Retinal fundus photograph.
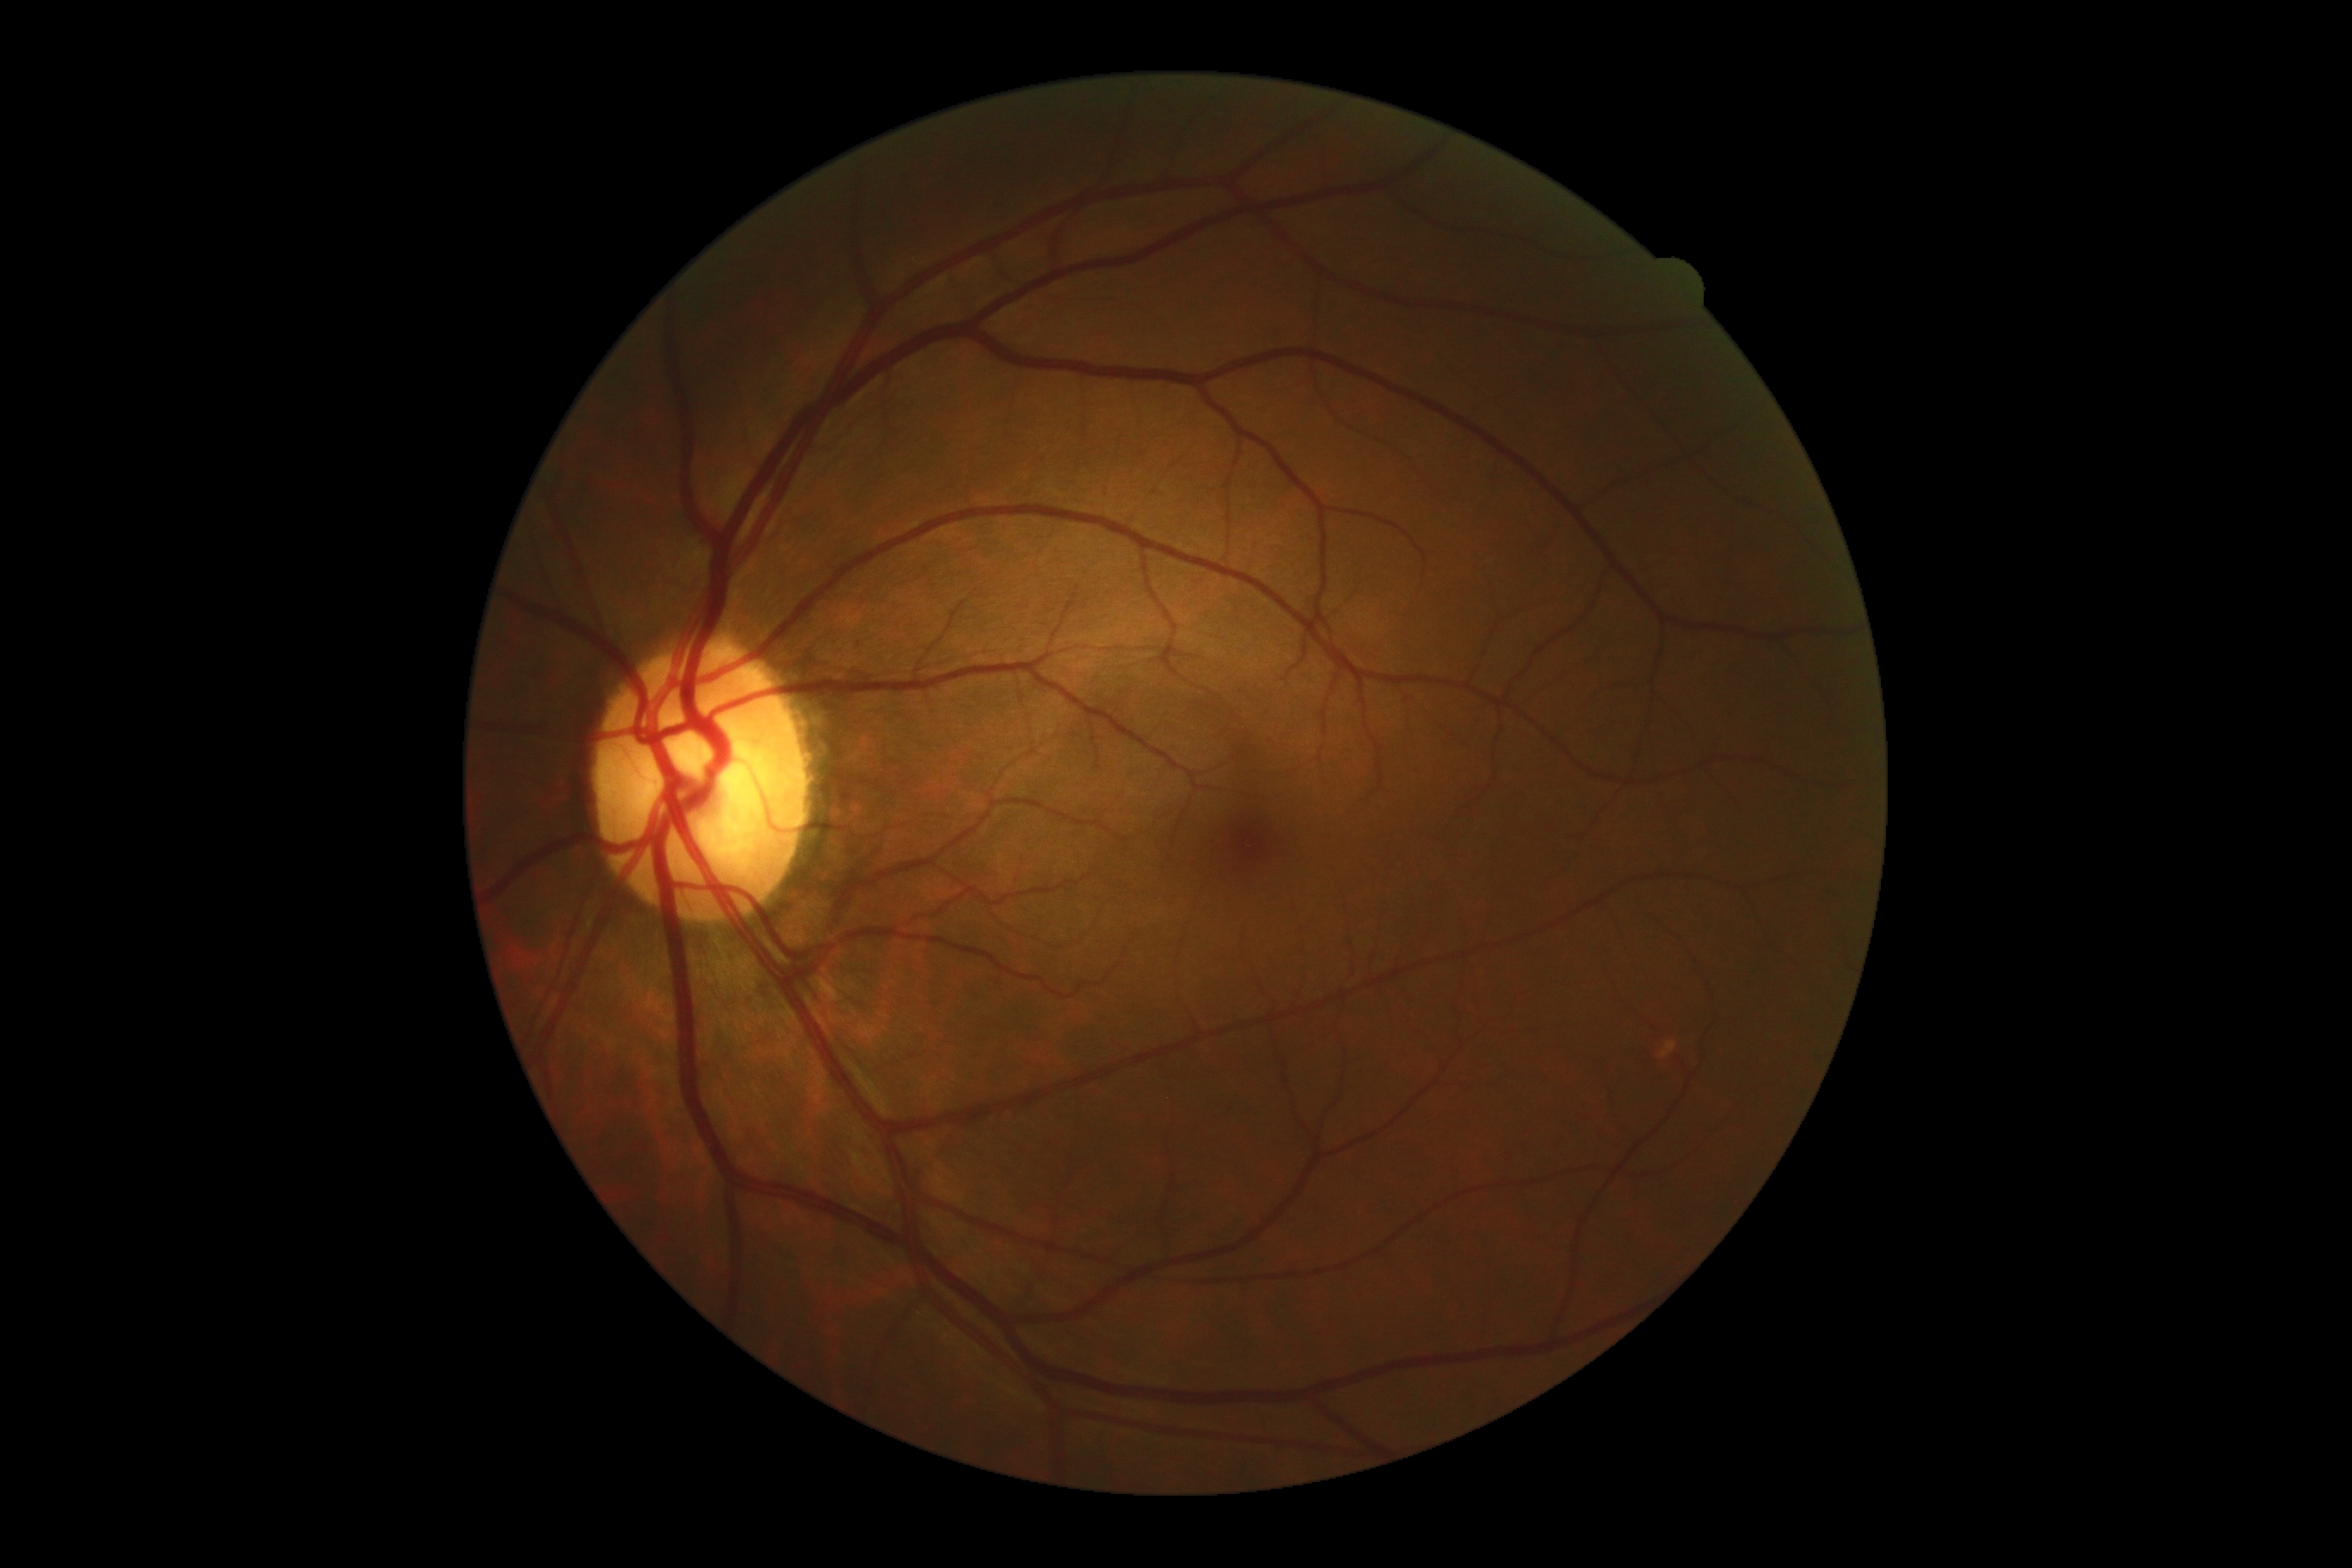
DR = no apparent retinopathy (grade 0); DR impression = no signs of DR.